45° field of view · no pharmacologic dilation.
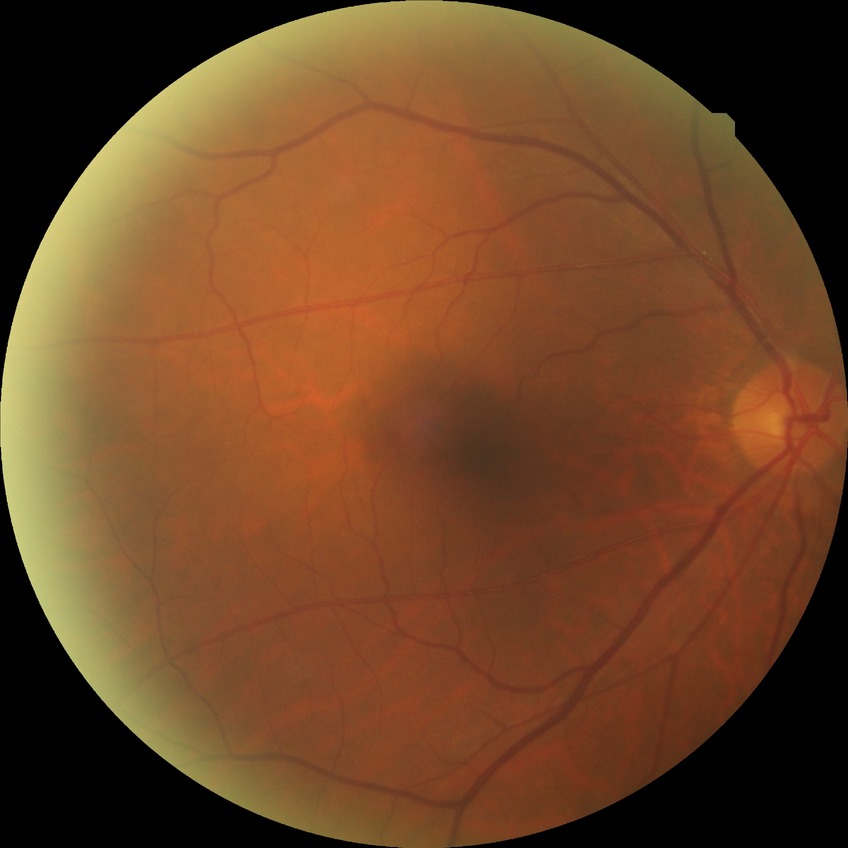

Diabetic retinopathy (DR): SDR (simple diabetic retinopathy).